Wide-field fundus photograph from neonatal ROP screening — 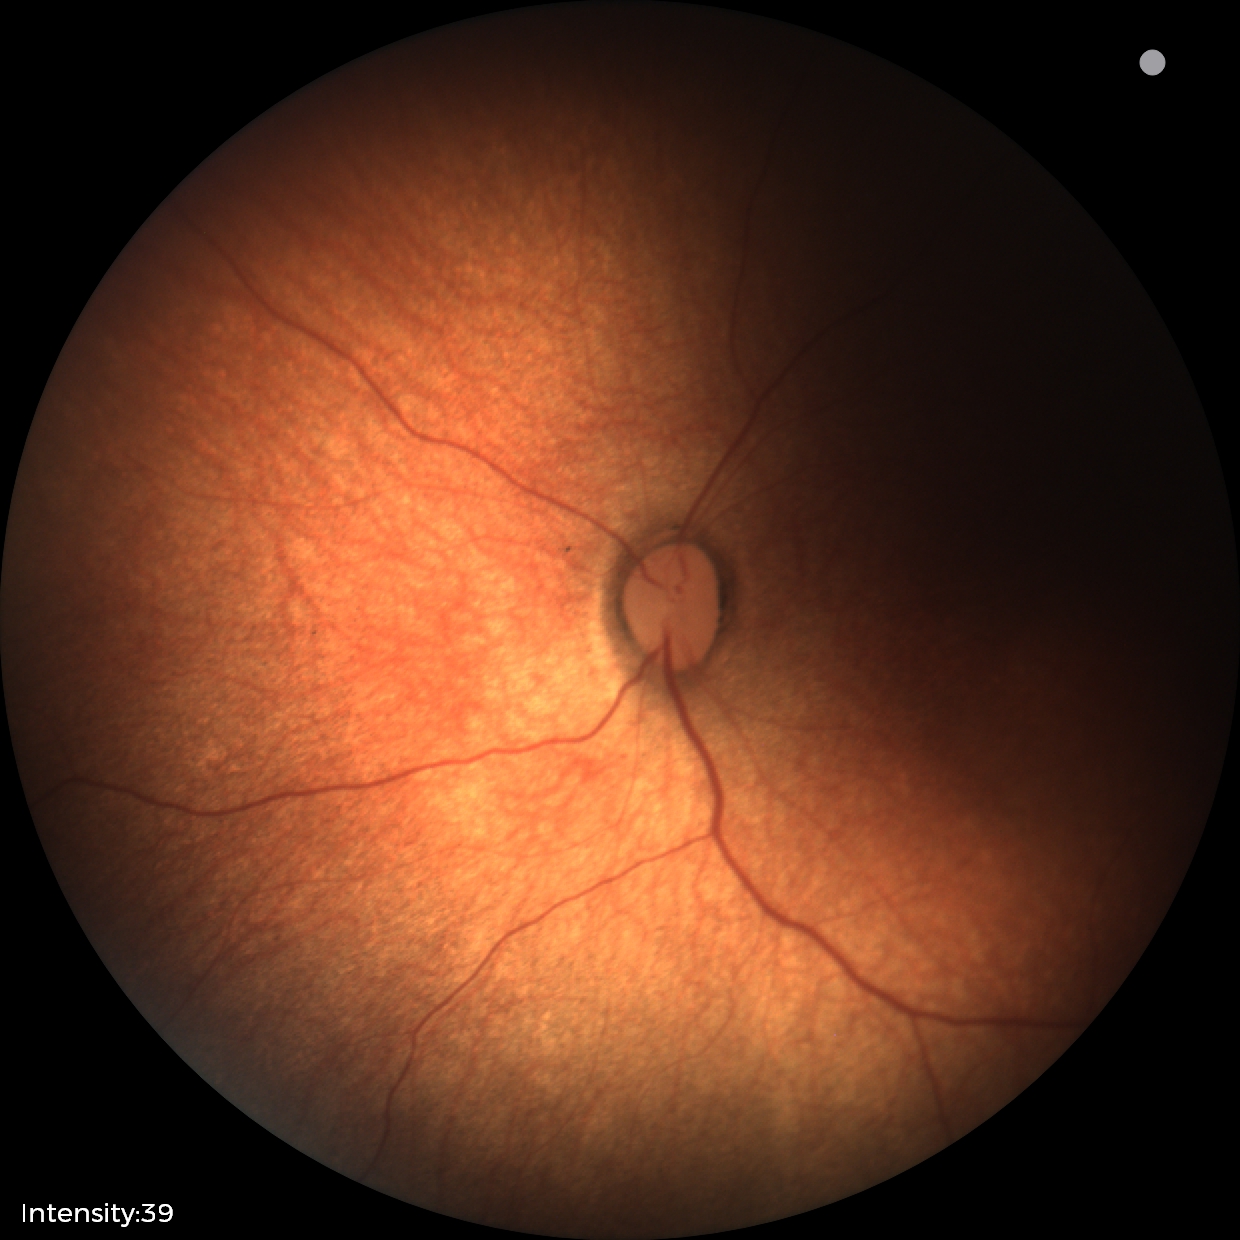 No retinal pathology identified on screening.